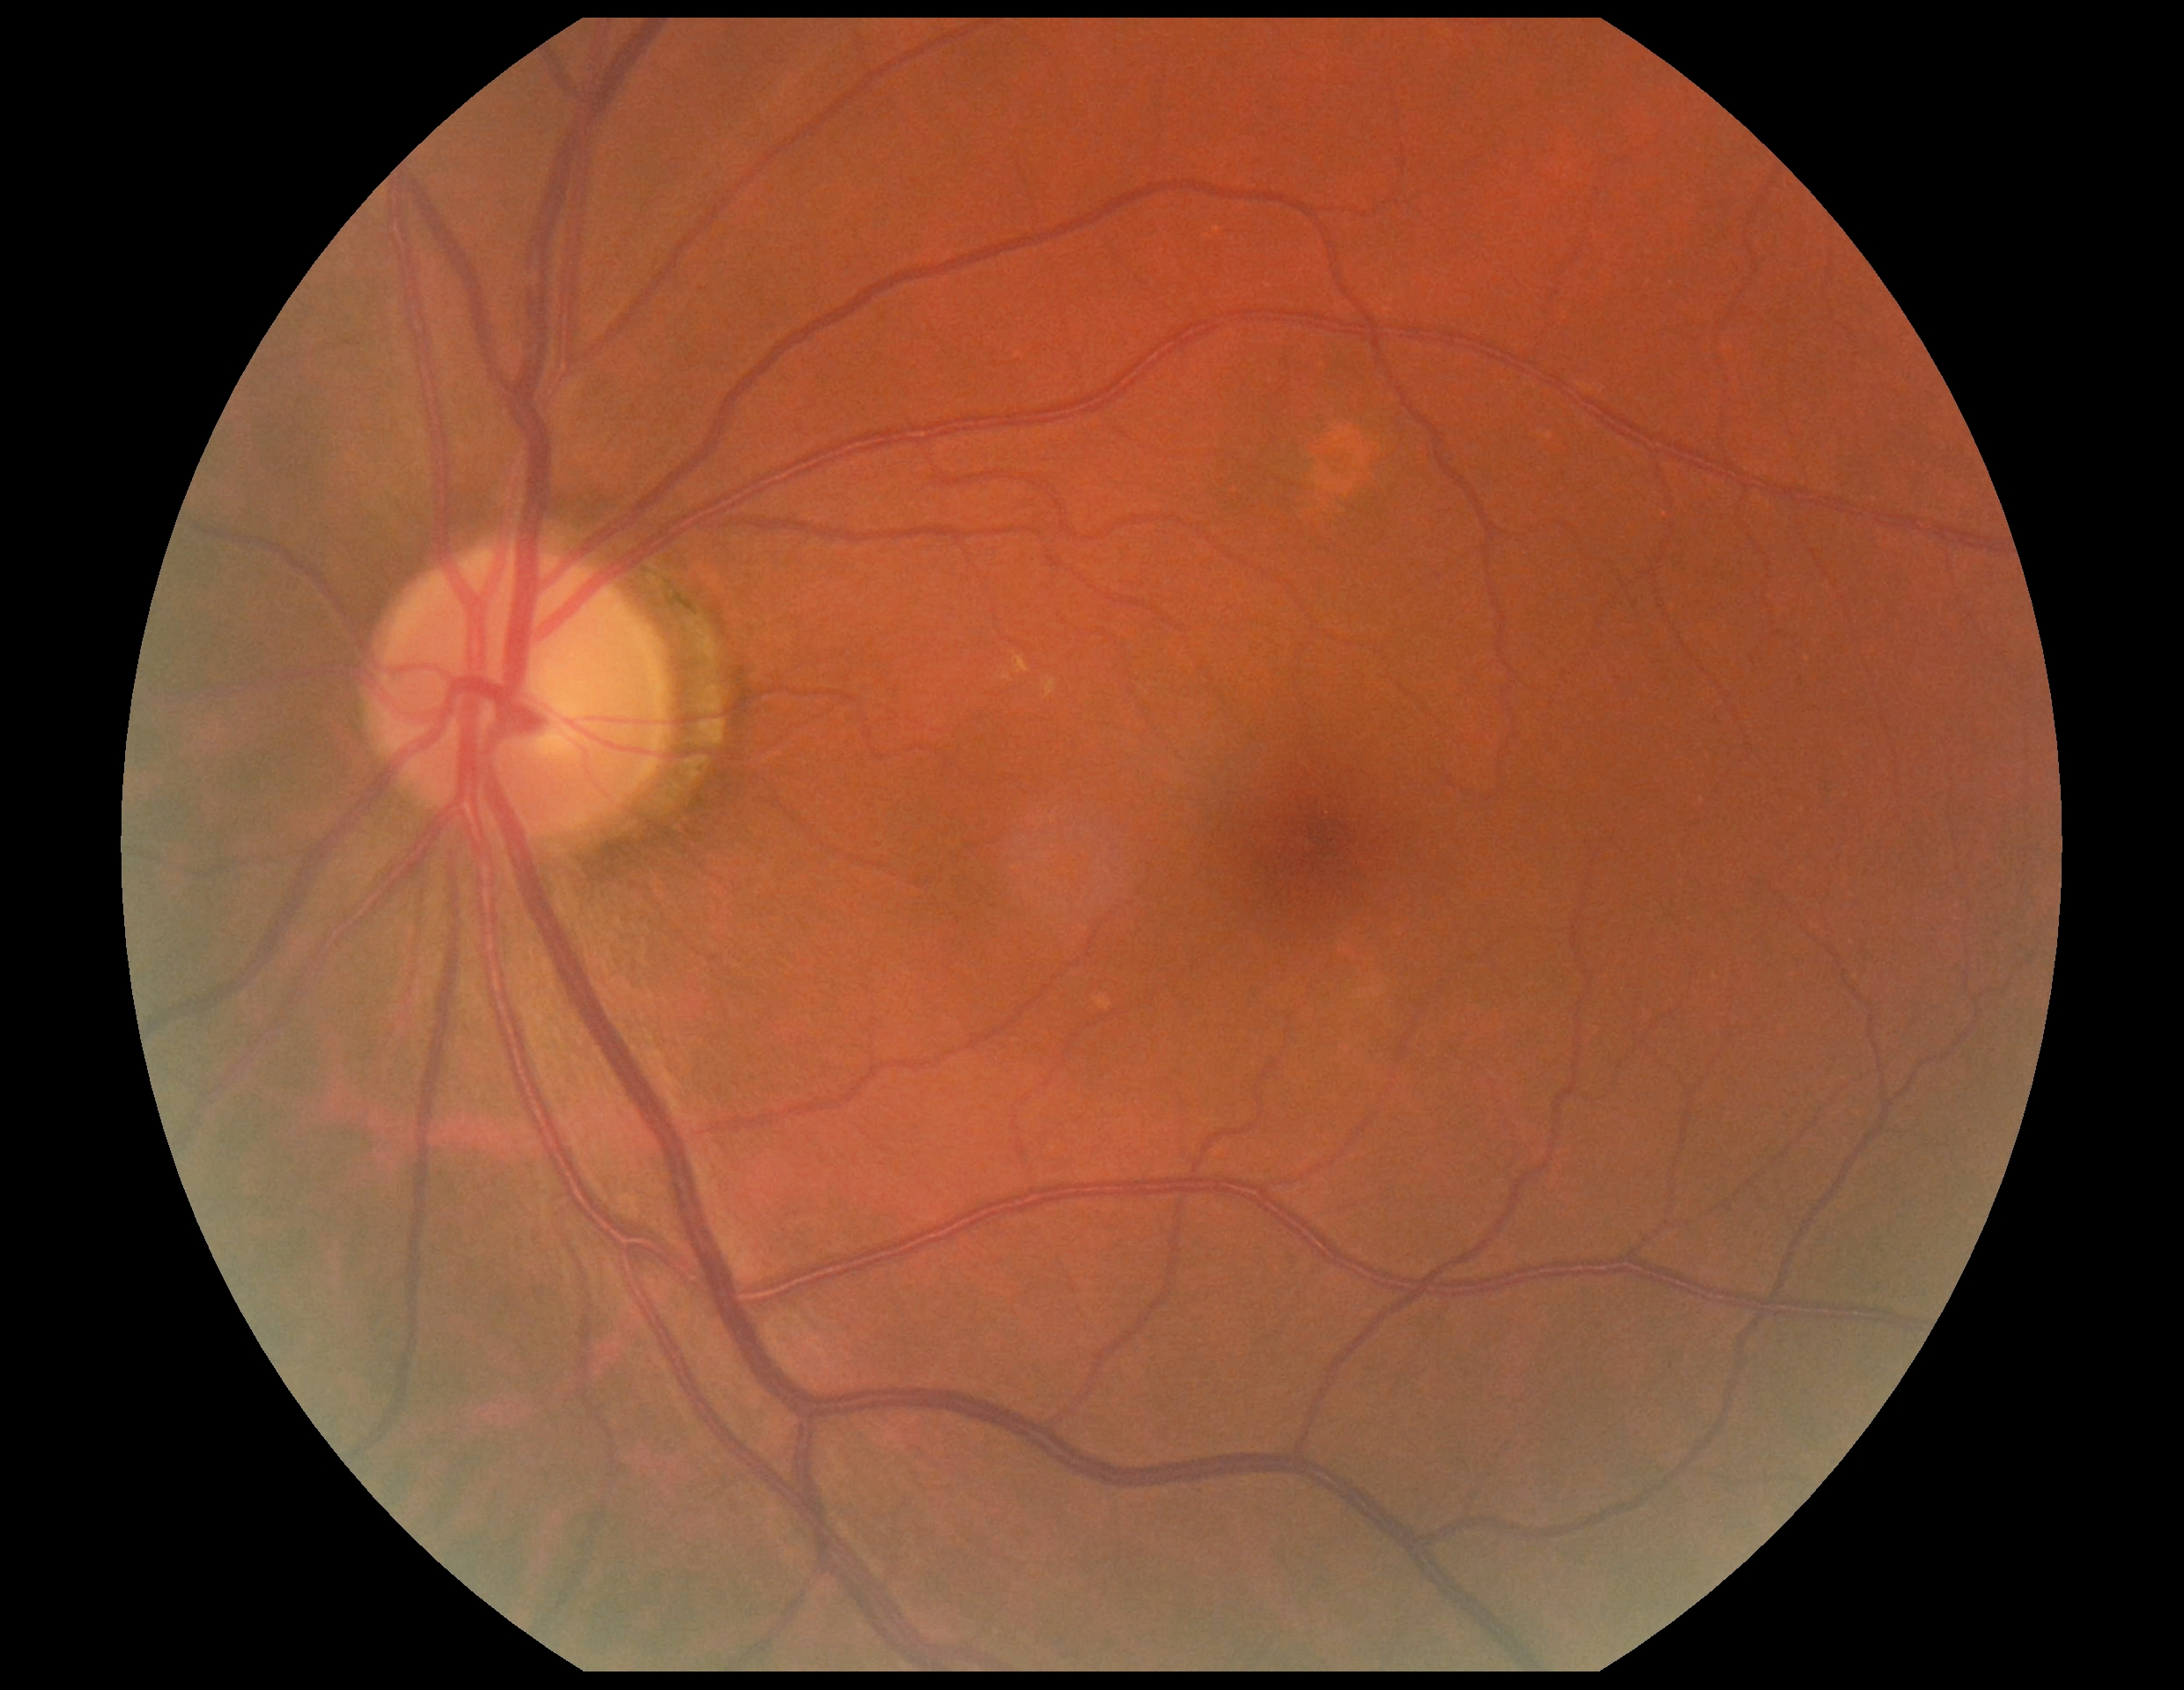 DR stage is grade 0 (no apparent retinopathy) — no visible signs of diabetic retinopathy.